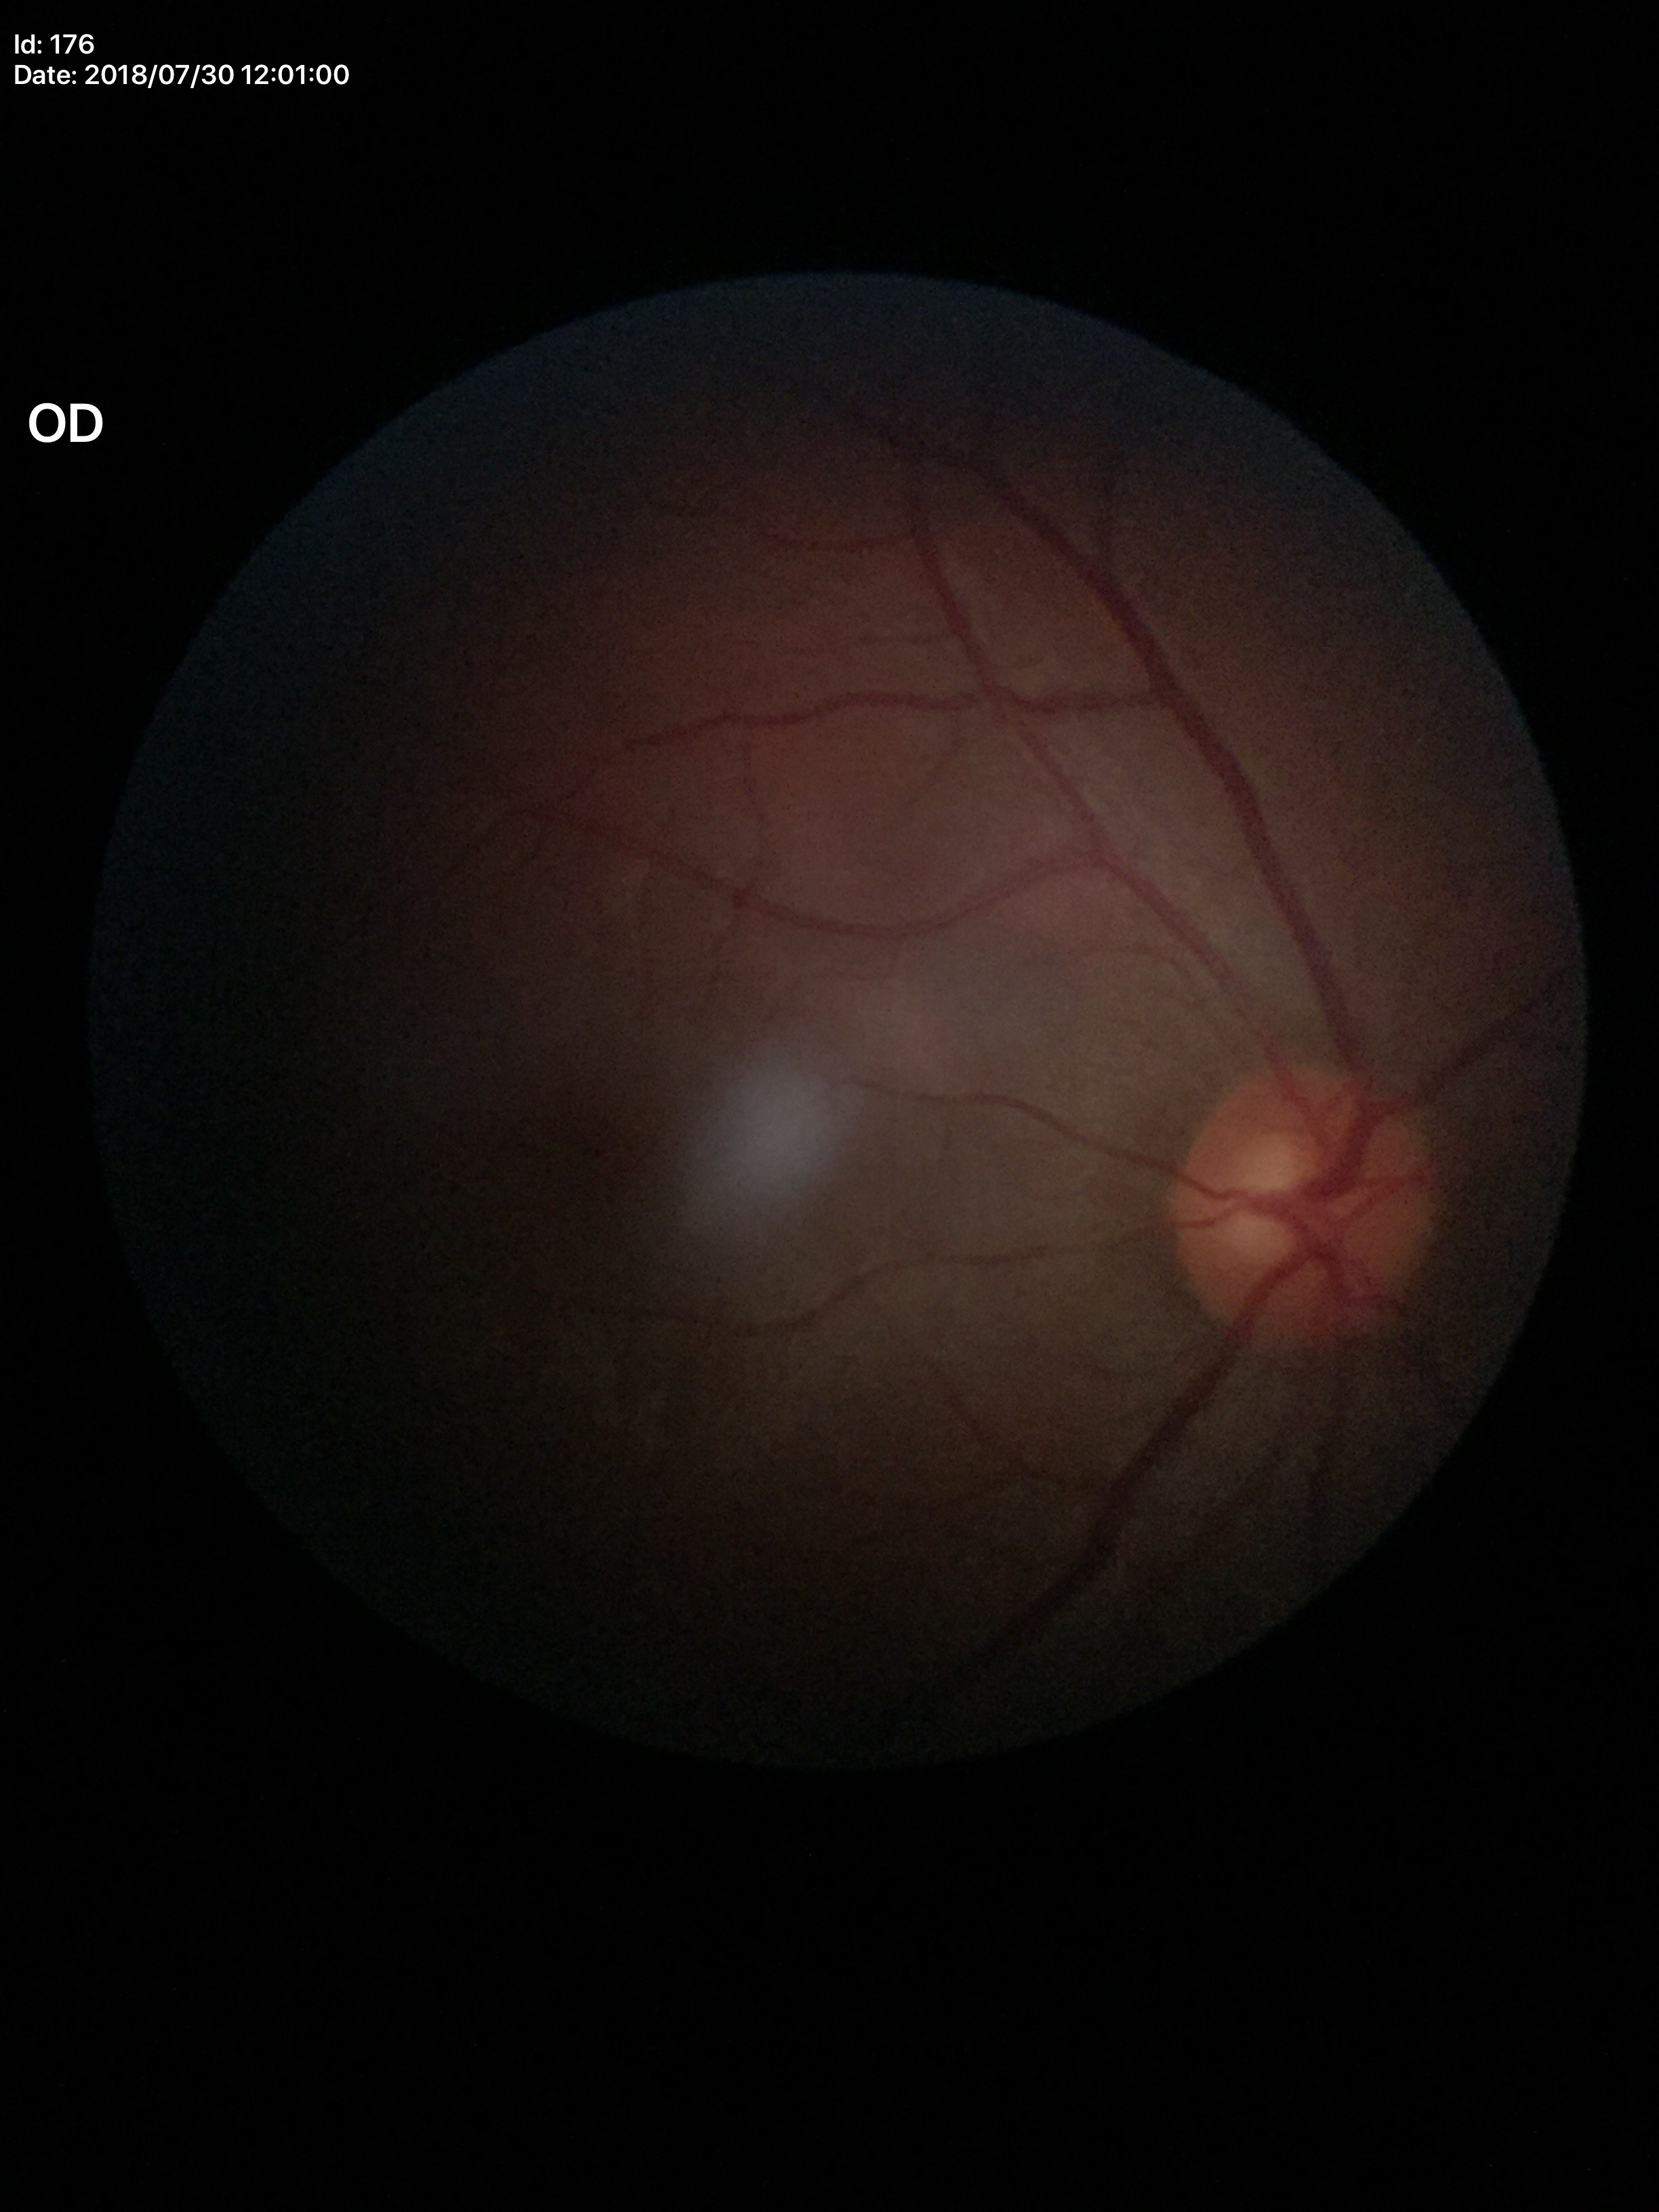

No glaucomatous findings.
Vertical CDR of 0.51.